Color fundus image; NIDEK AFC-230; 848 by 848 pixels; 45° FOV — 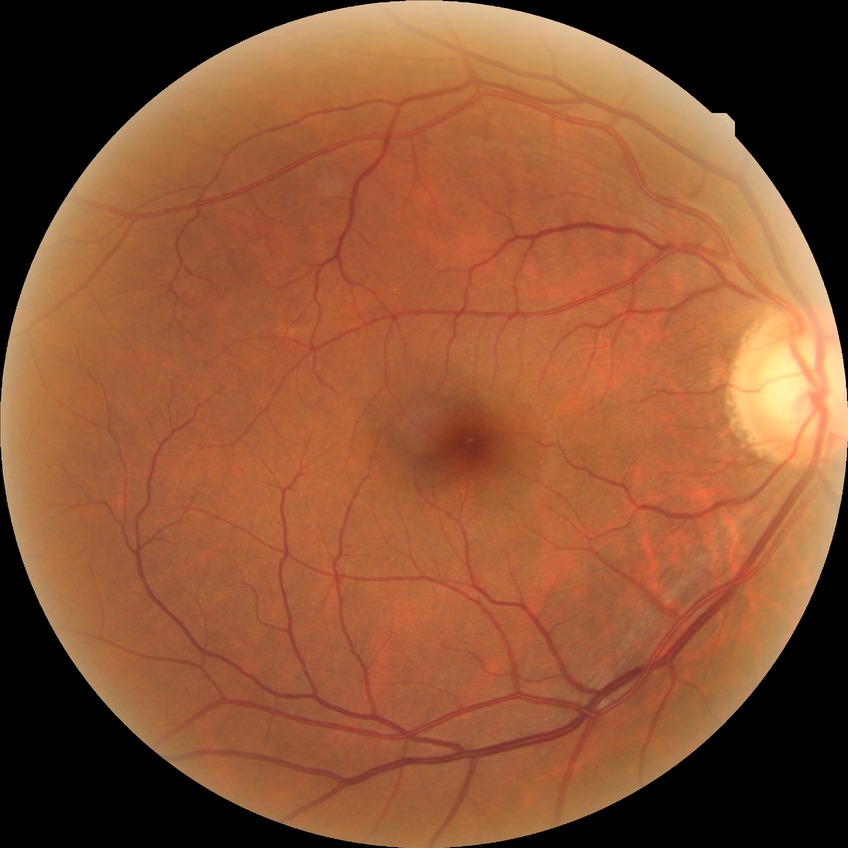
Assessment:
* diabetic retinopathy (DR) — no diabetic retinopathy (NDR)